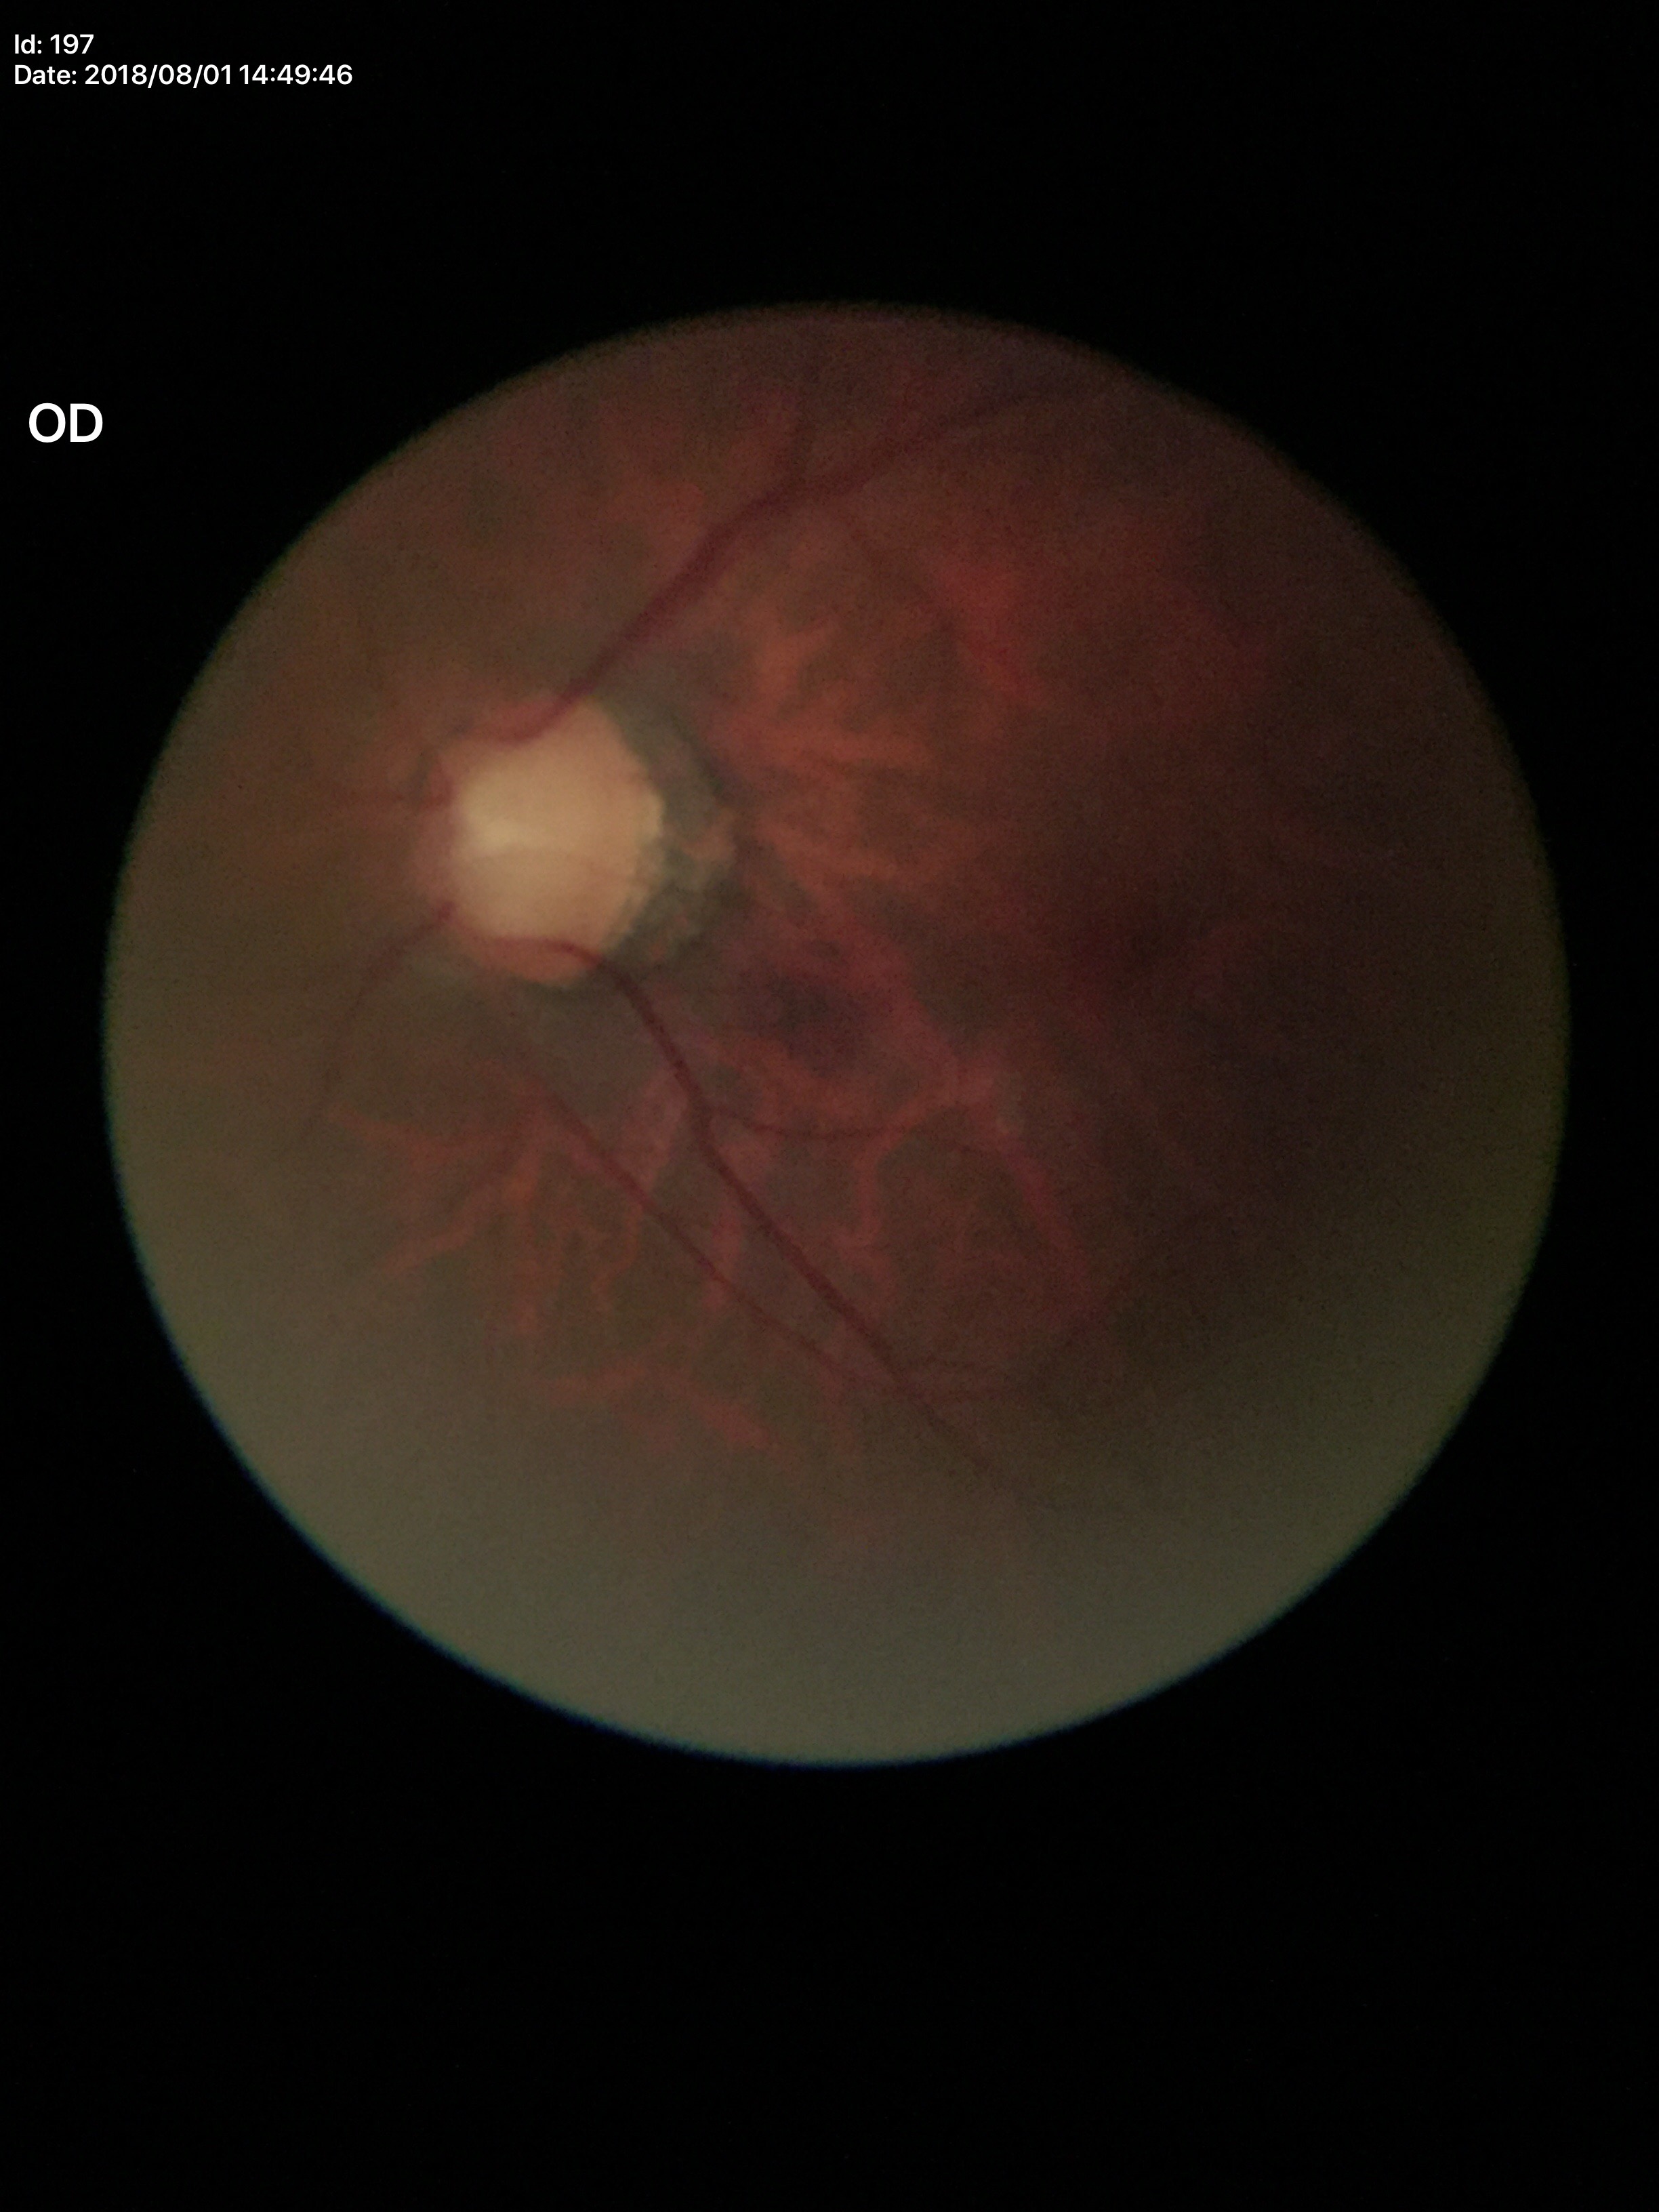

Findings:
– Glaucoma impression — suspicious
– vertical C/D ratio (VCDR) — 0.71
– area cup-to-disc ratio (ACDR) — 0.50